Nonmydriatic fundus photograph, NIDEK AFC-230, 848 x 848 pixels, 45° FOV
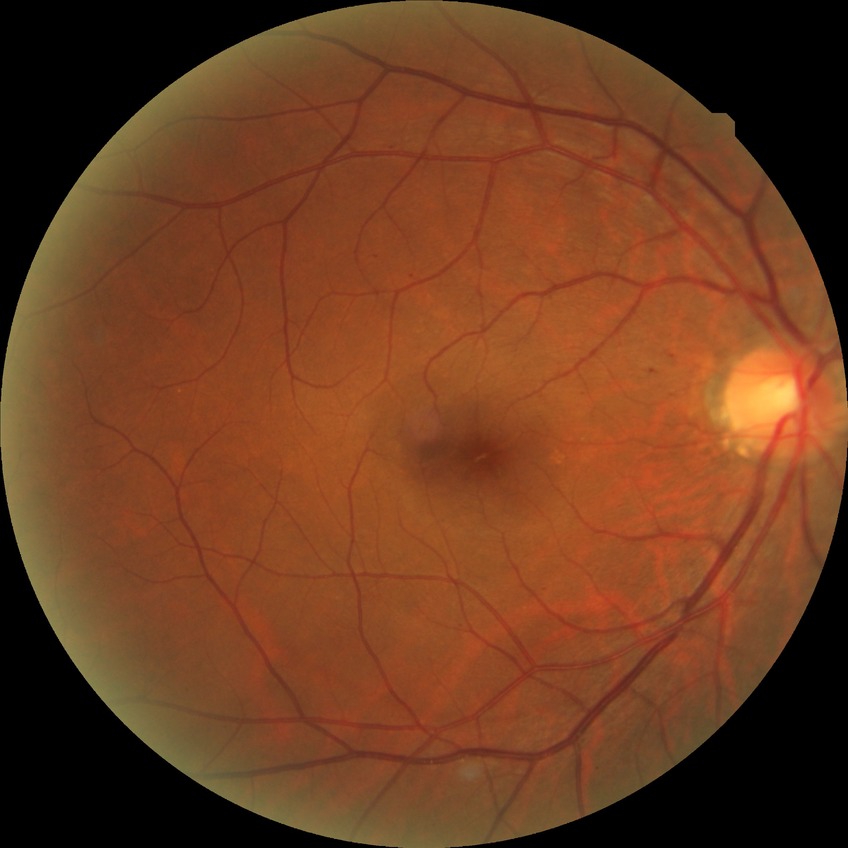 The retinopathy is classified as non-proliferative diabetic retinopathy.
Davis stage is SDR.